Camera: Phoenix ICON (100° FOV). Image size 1240x1240. Infant wide-field fundus photograph
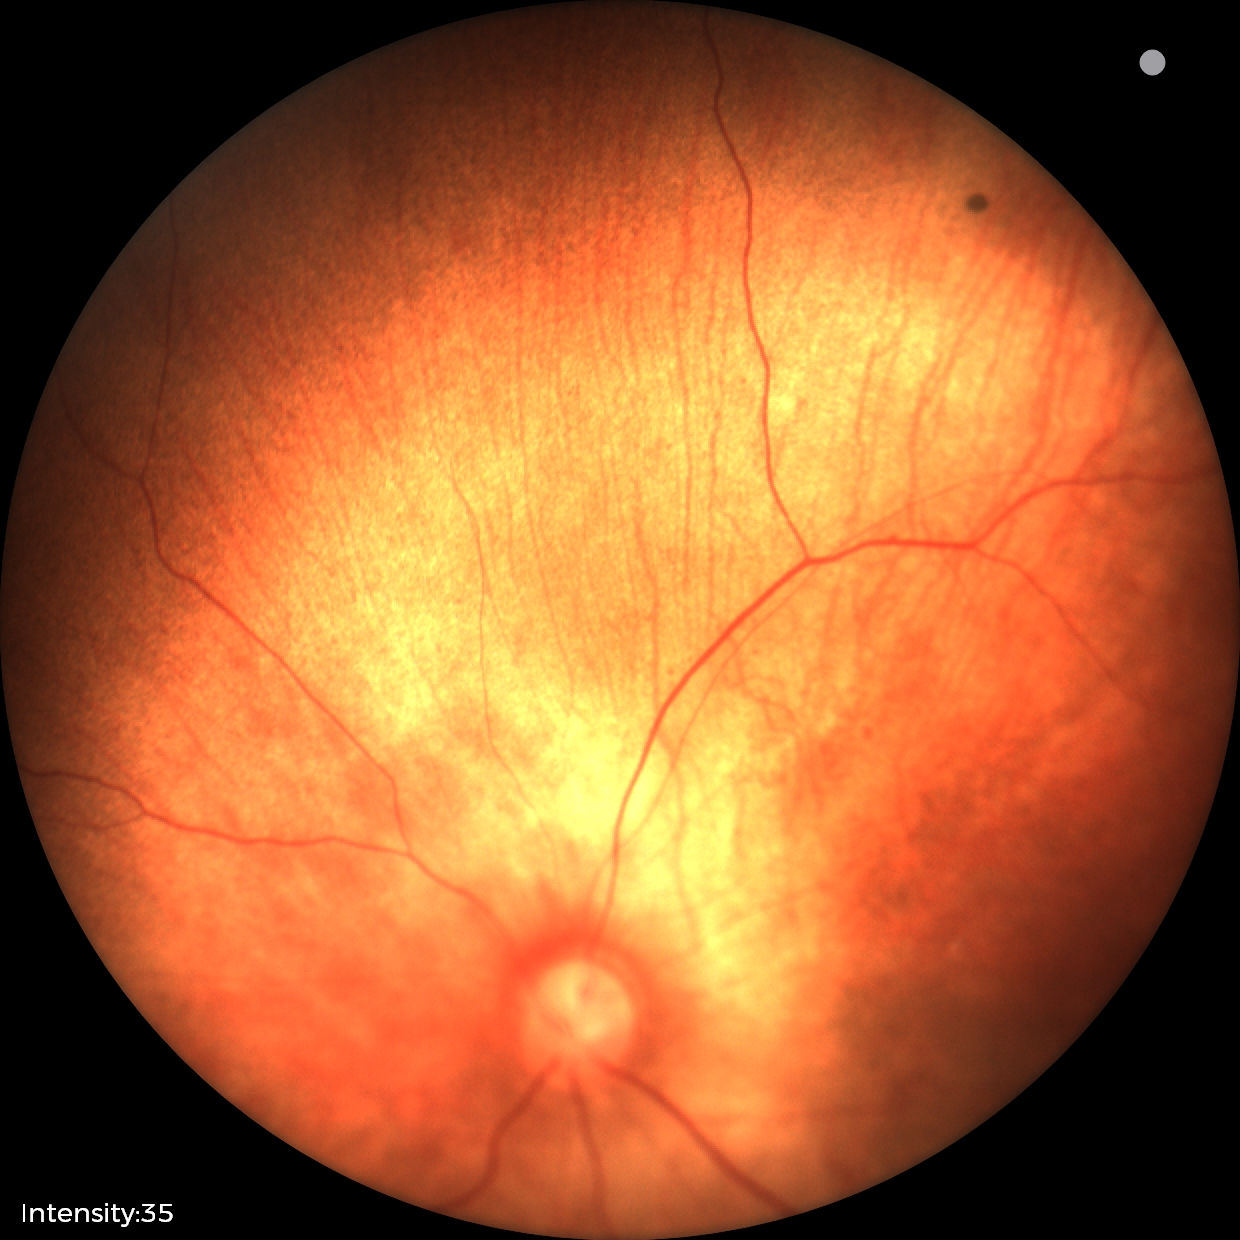

Diagnosis: physiological.